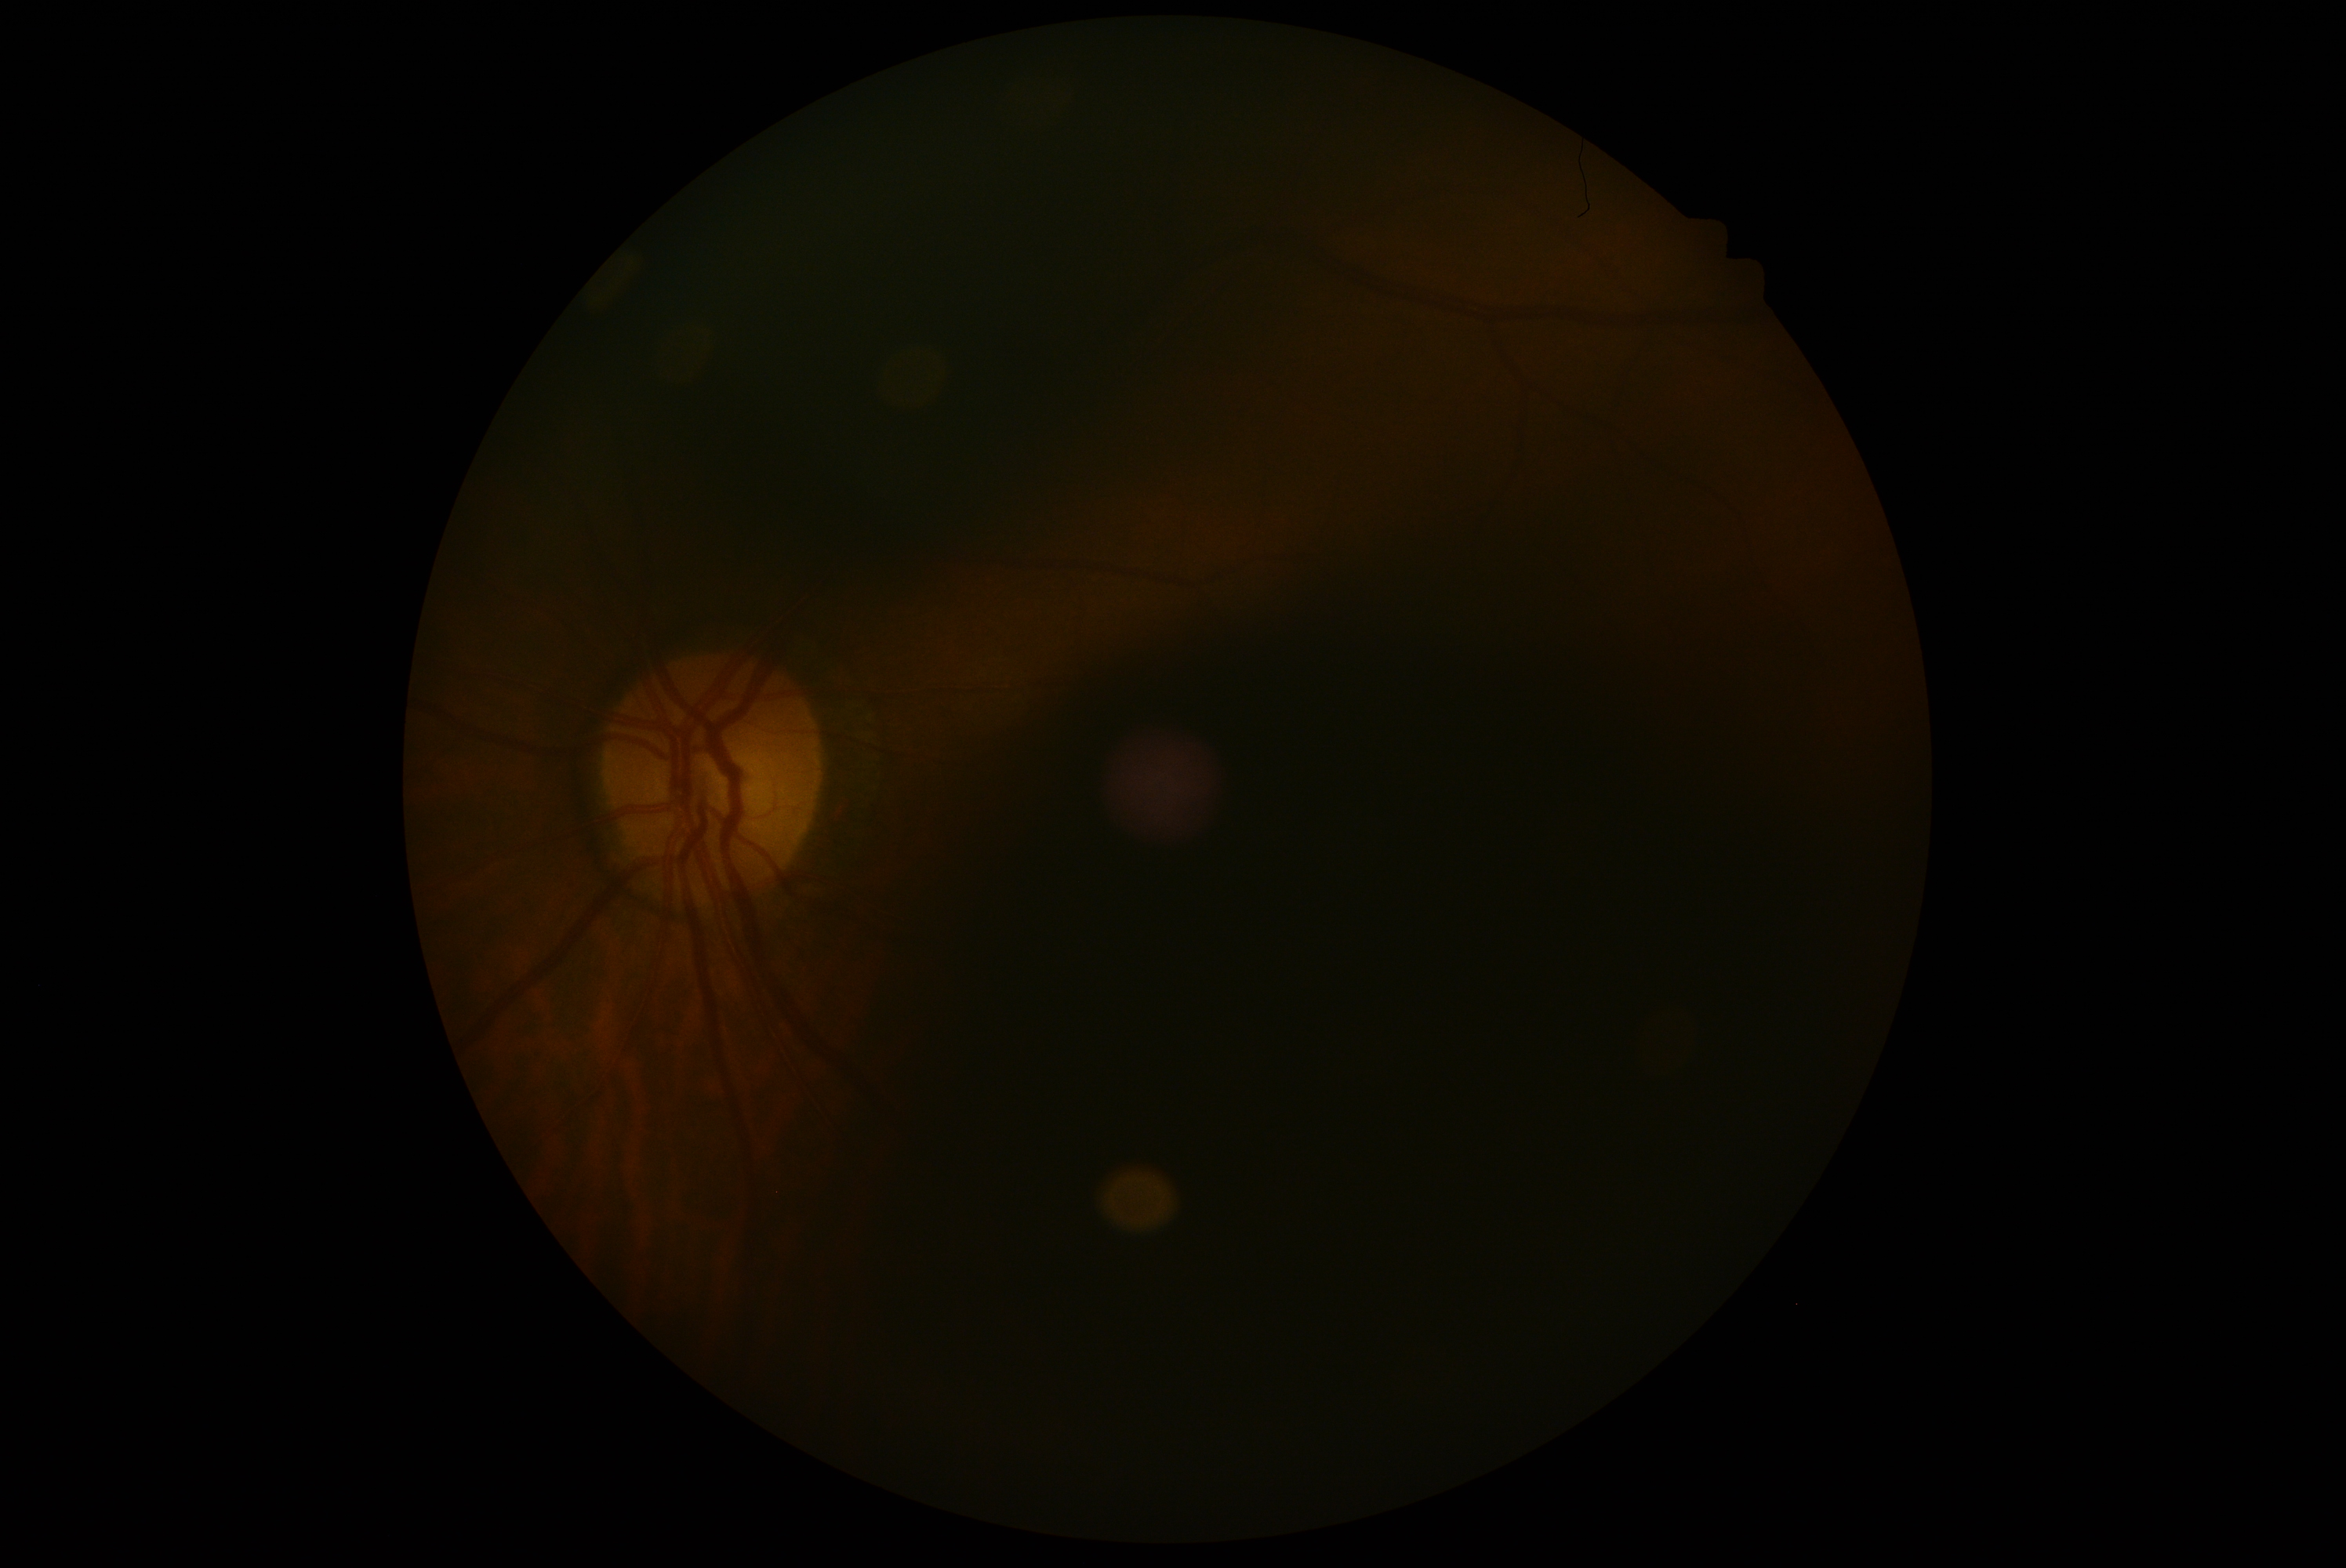 {"dr_grade": "ungradable", "quality": "too poor for DR grading"}